Acquired with a Remidio smartphone fundus camera — 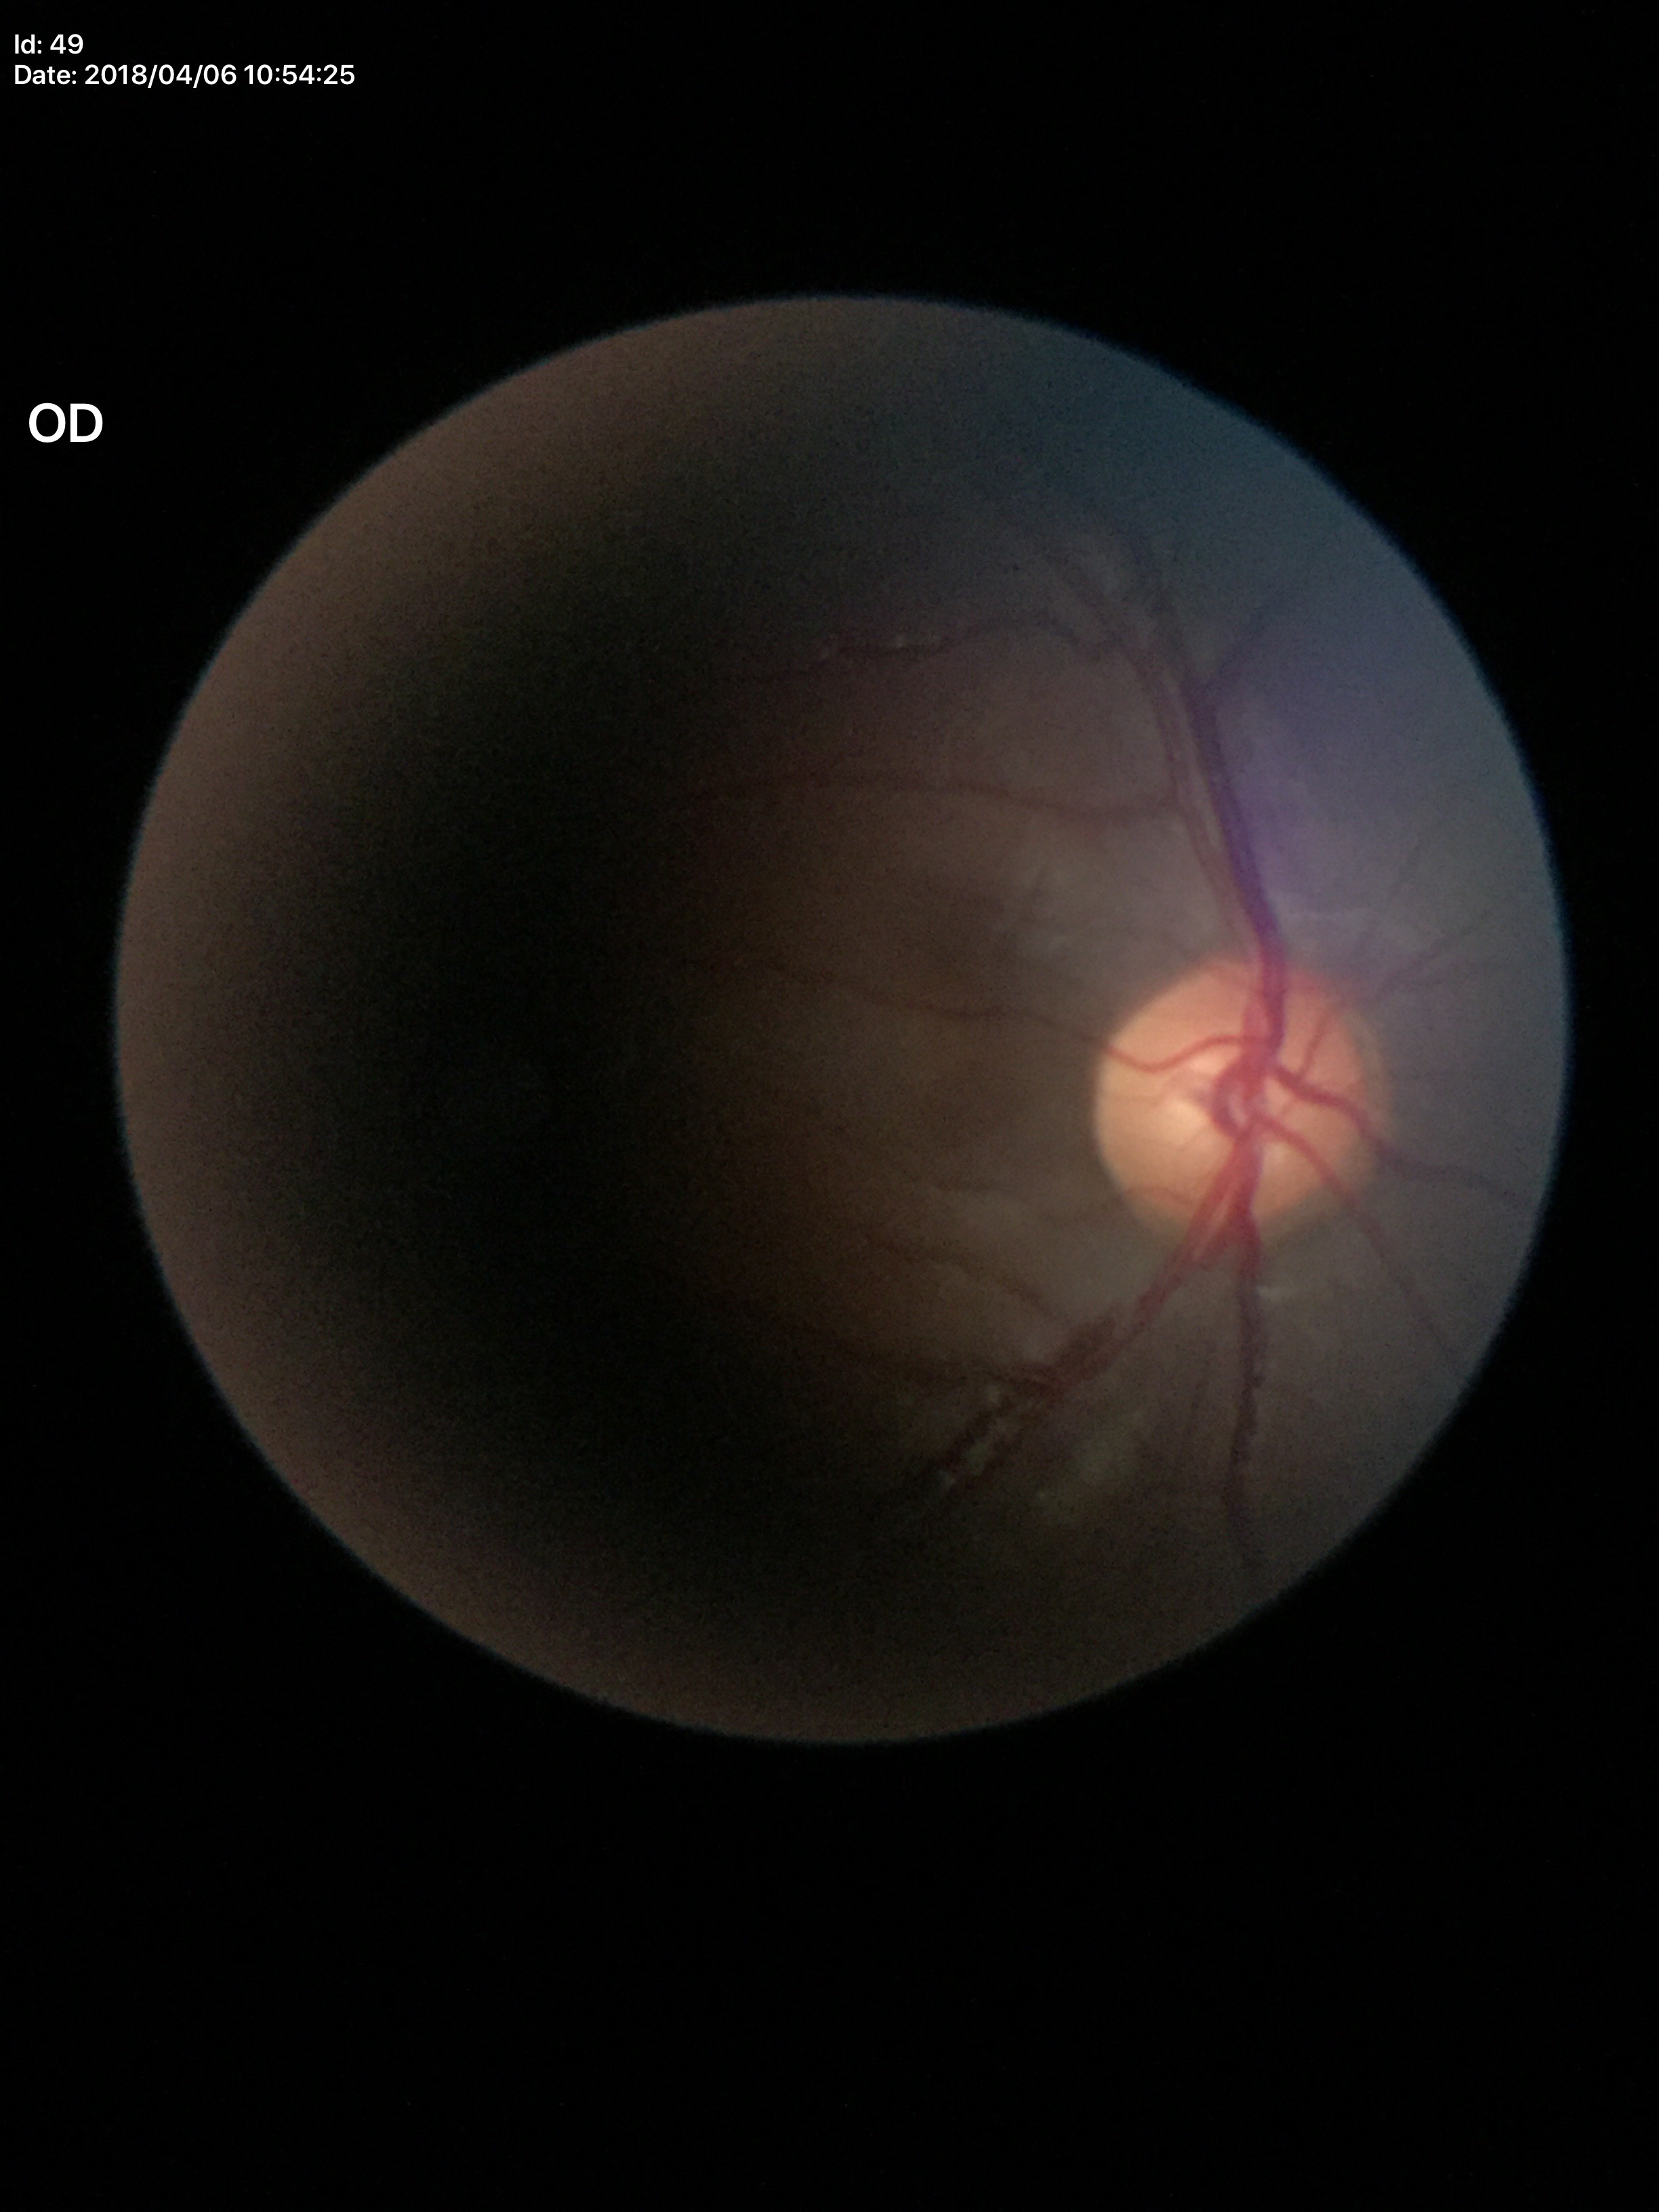

No glaucomatous findings (one of five ophthalmologists flagged glaucoma suspect). Vertical cup-to-disc ratio (VCDR) of 0.56.